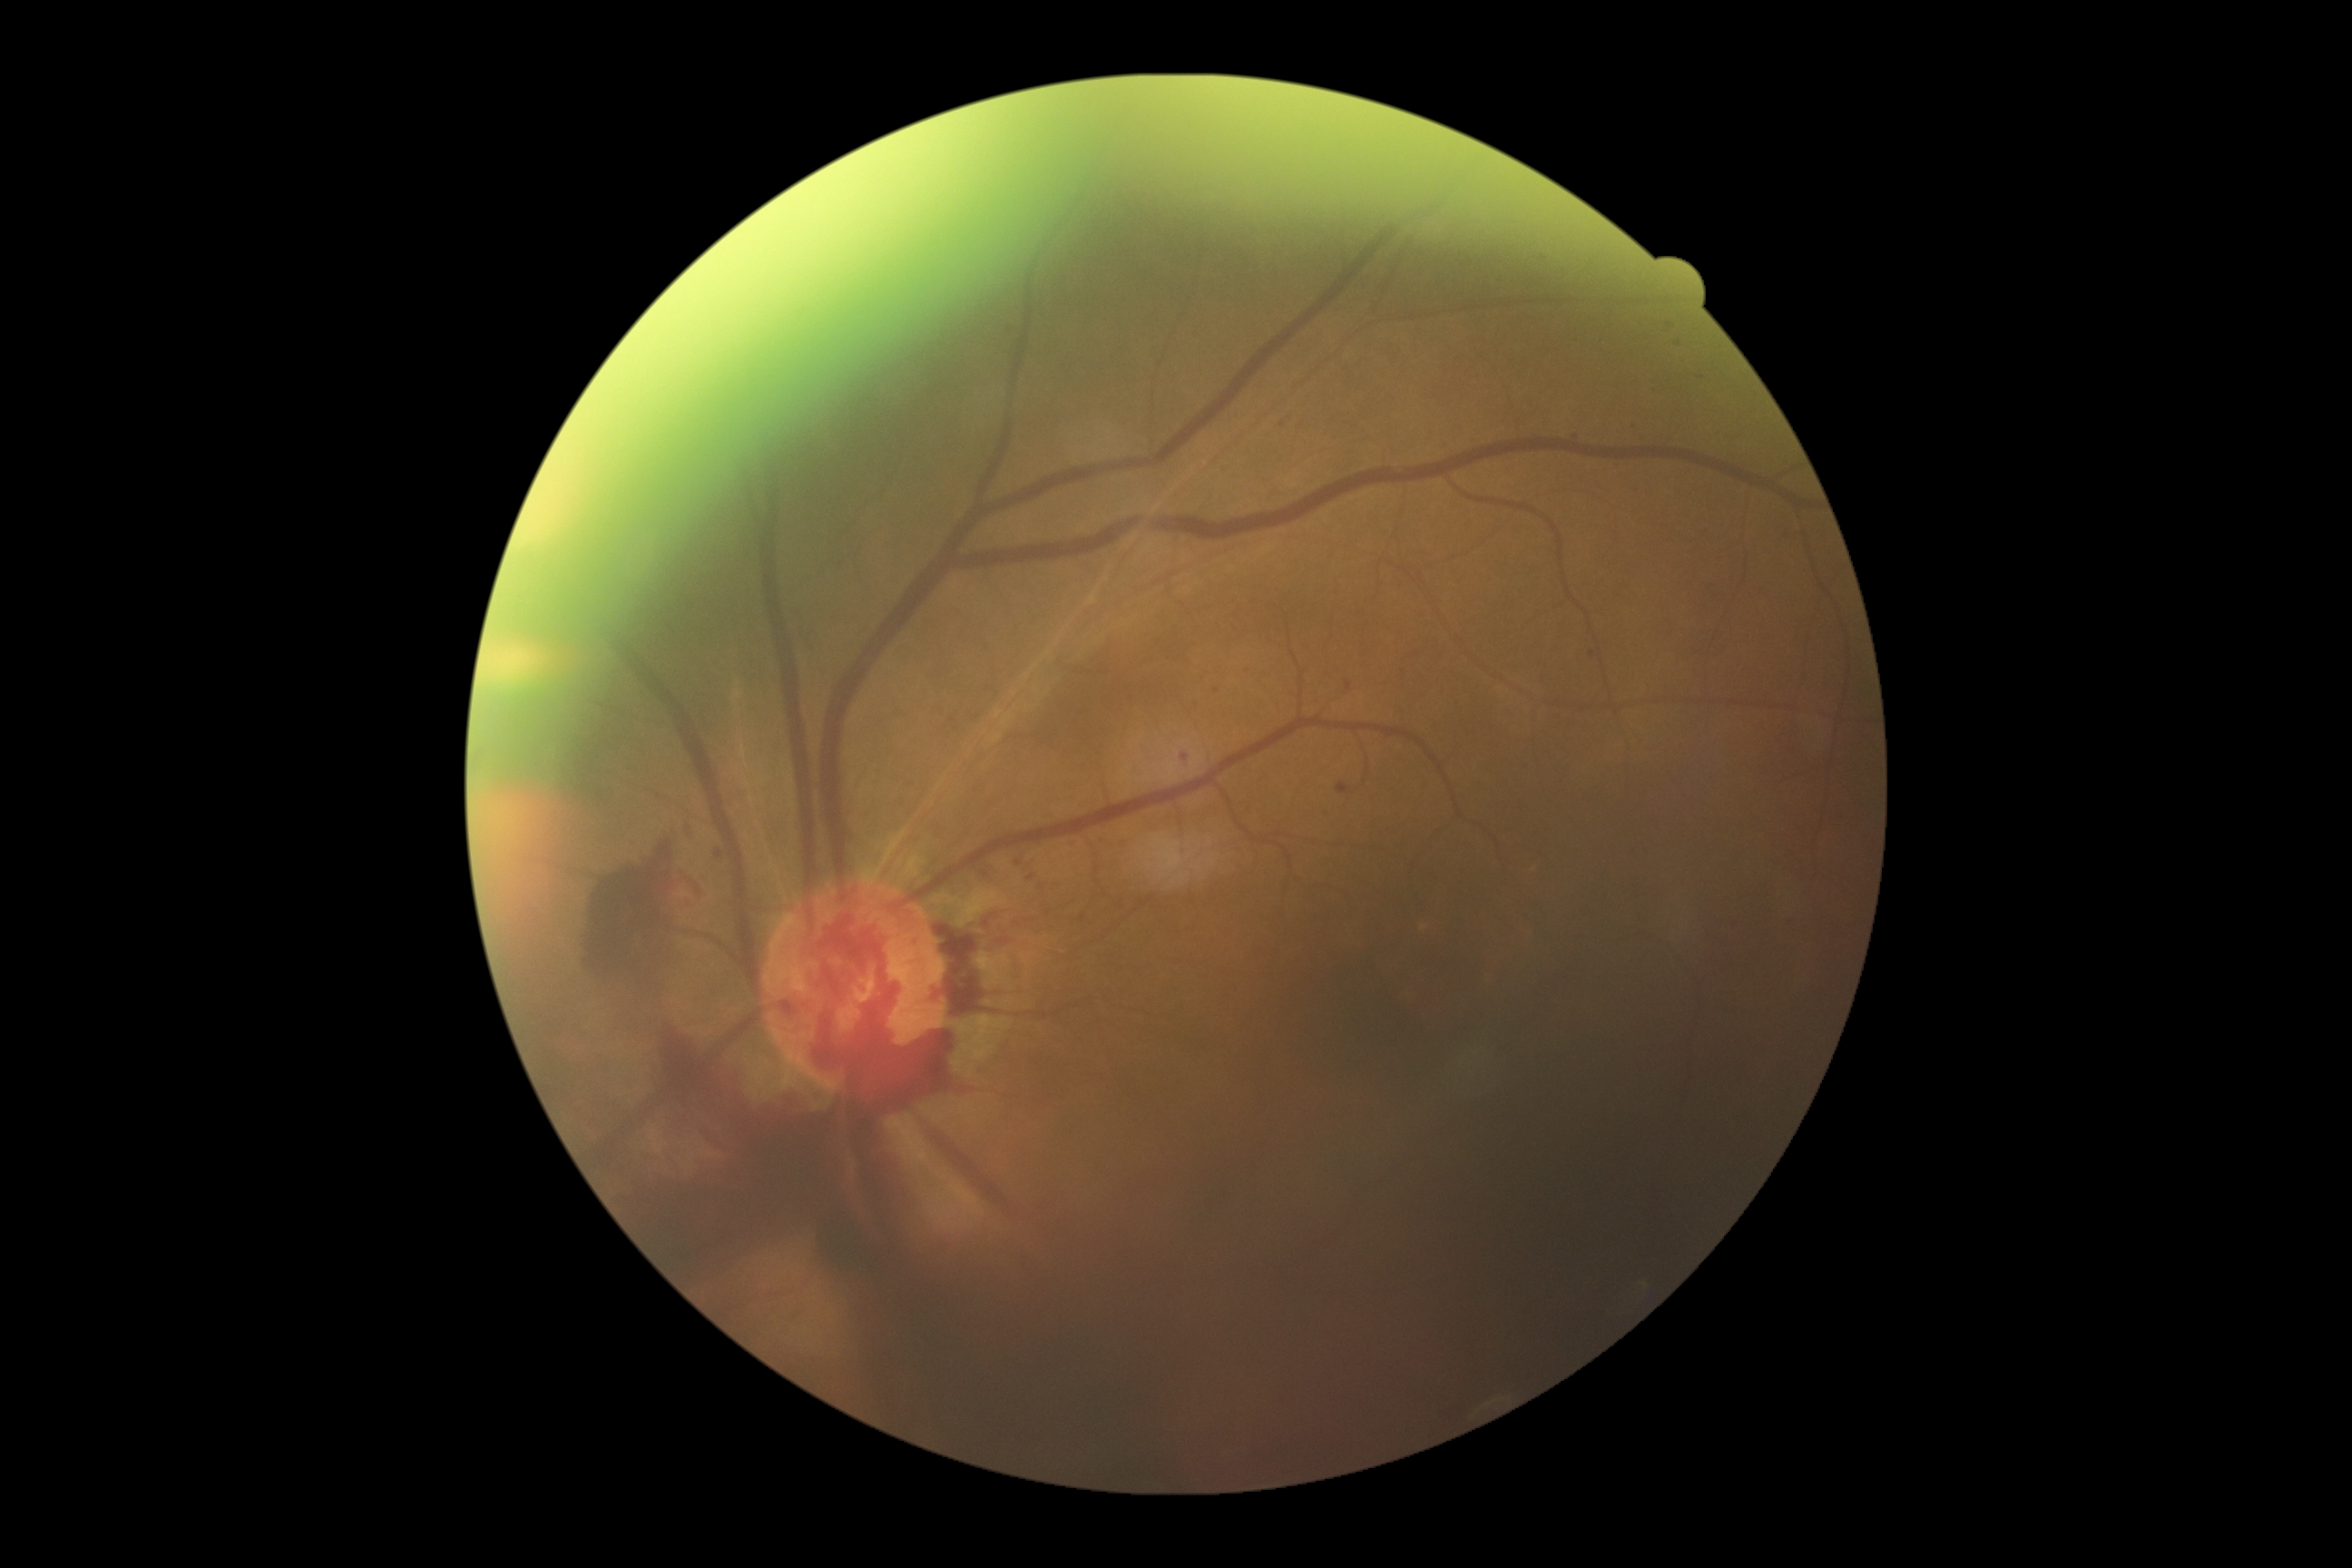

Diabetic retinopathy (DR) is grade 4 (PDR).